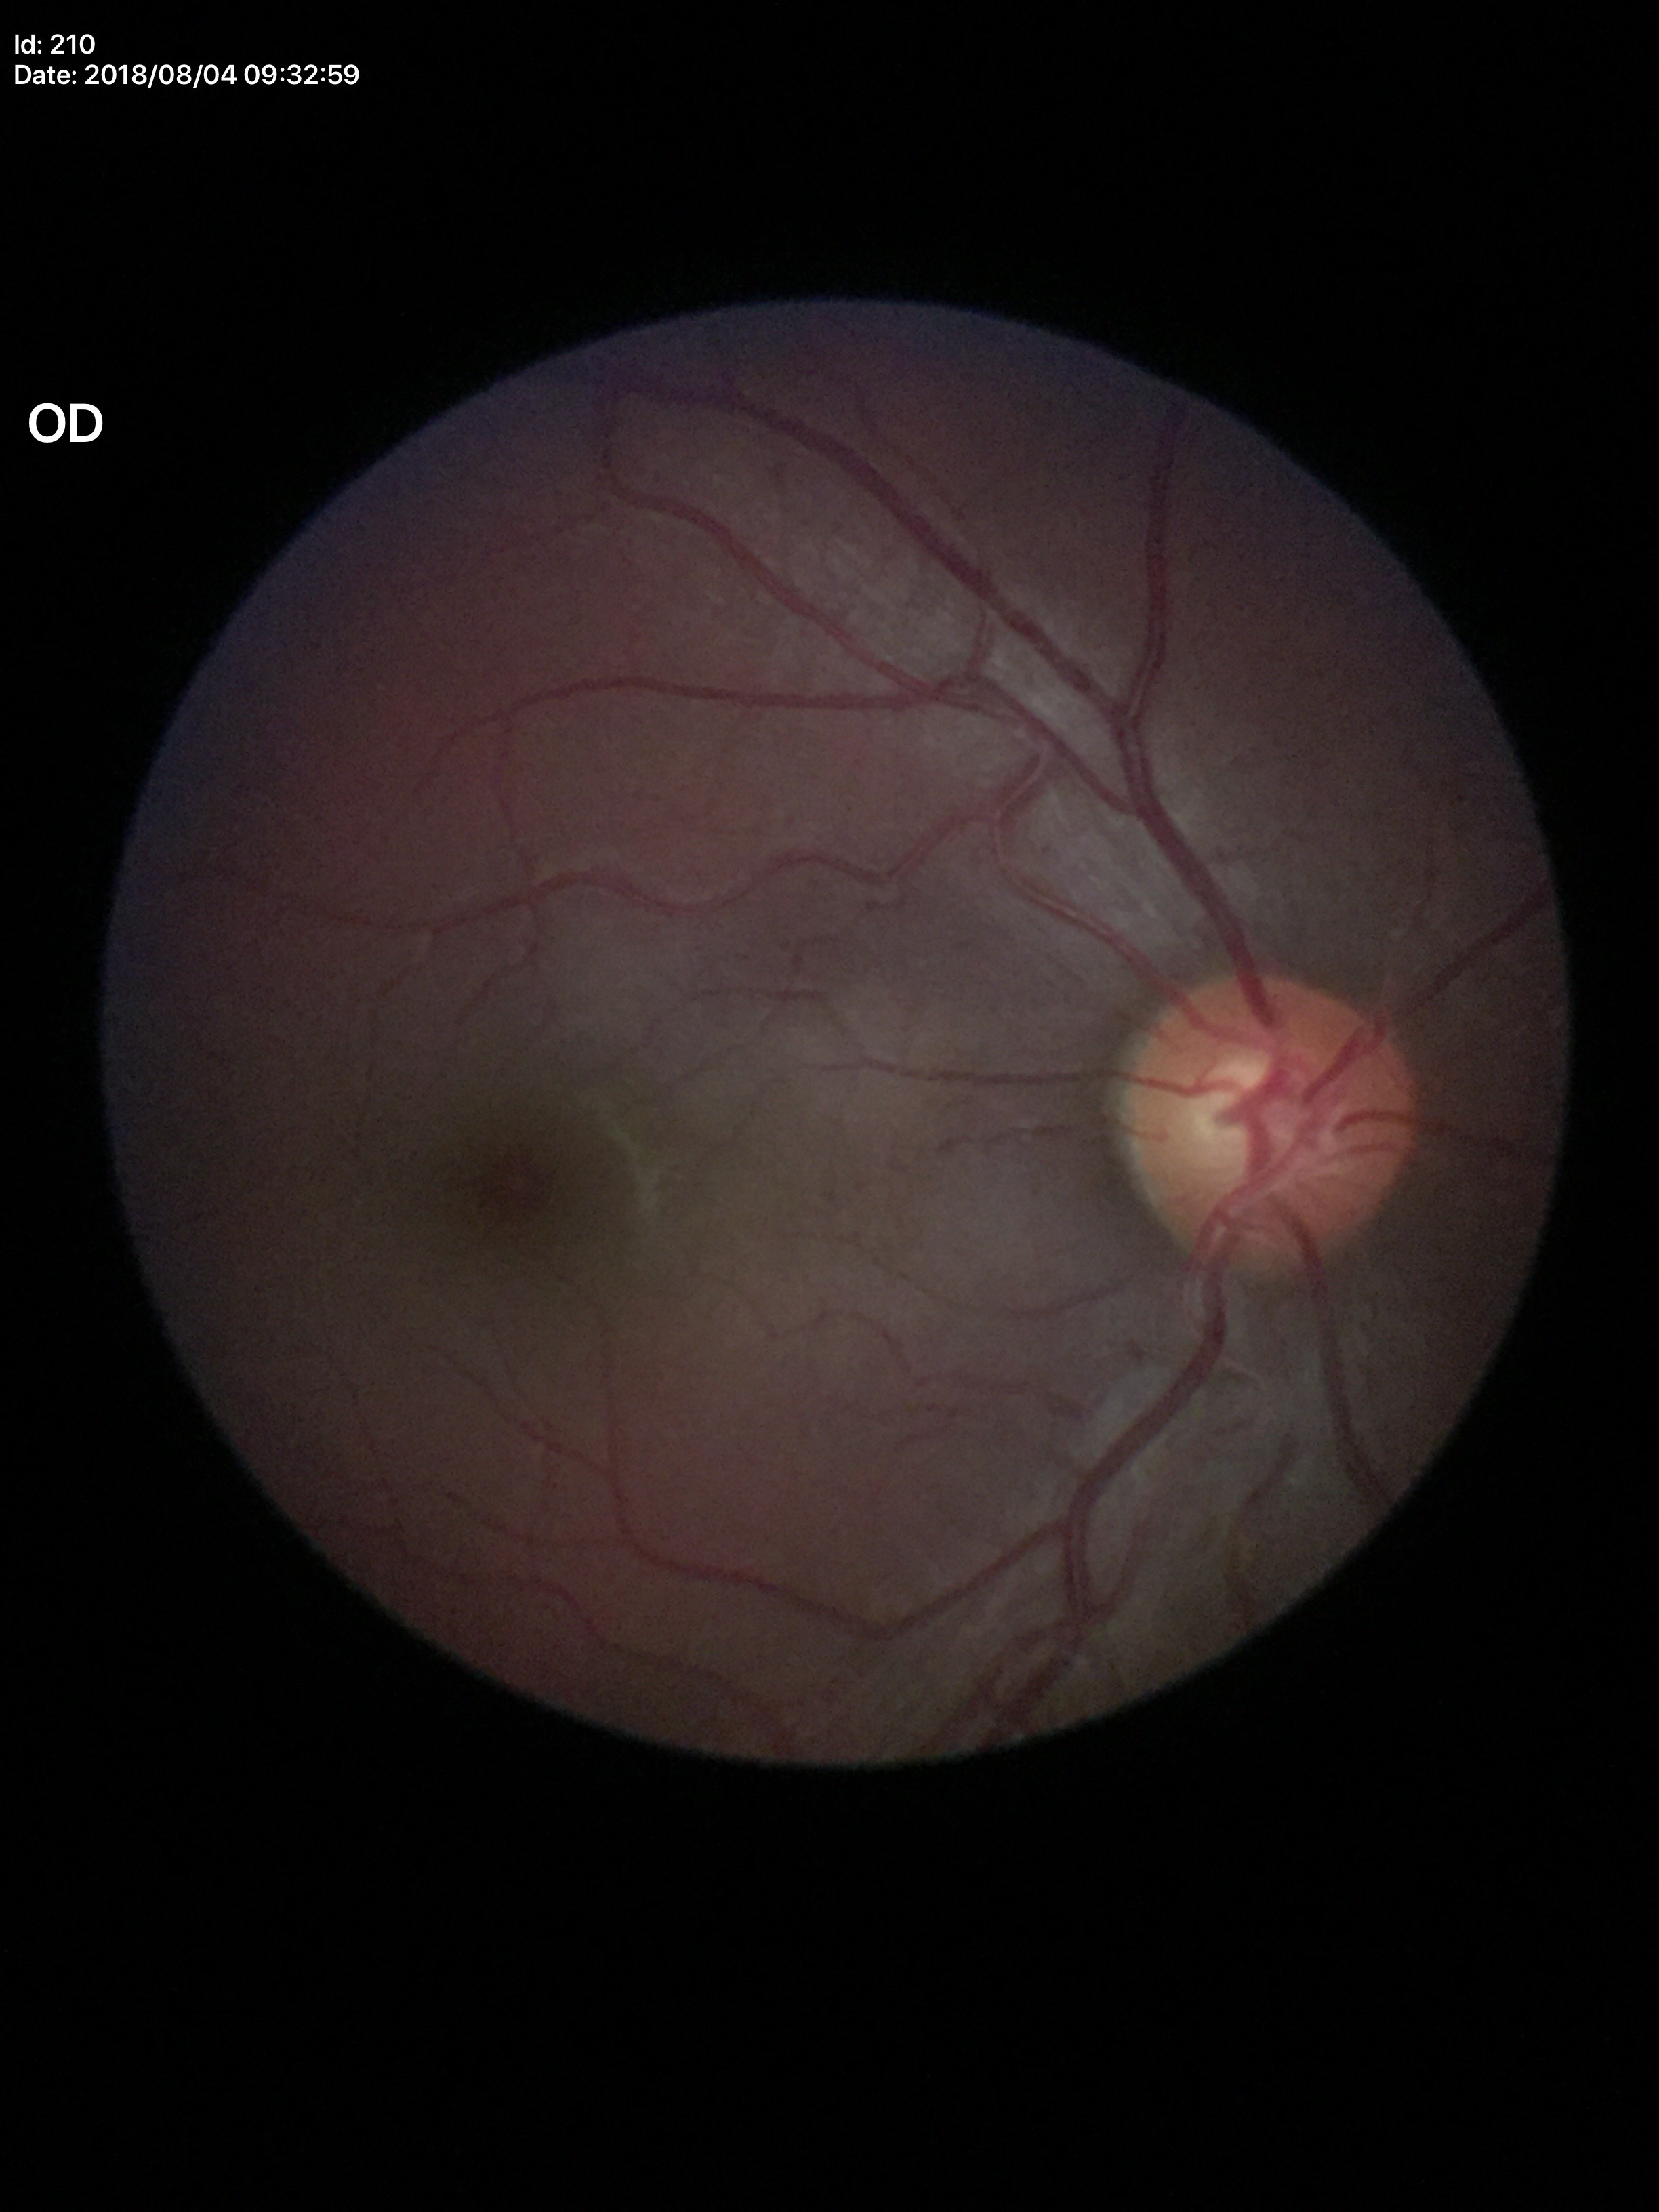

Glaucoma screening impression = negative | vertical cup-to-disc ratio (VCDR) = 0.54 | horizontal cup-disc ratio (HCDR) = 0.51.